No pharmacologic dilation, Davis DR grading, NIDEK AFC-230 fundus camera — 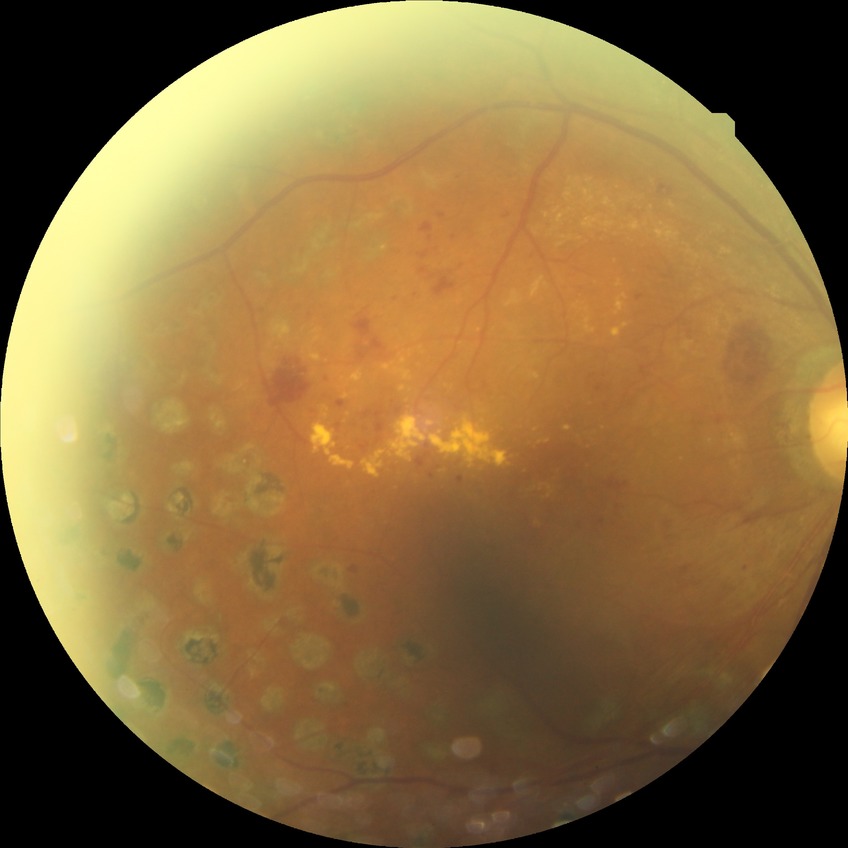
davis_grade: proliferative diabetic retinopathy (PDR)